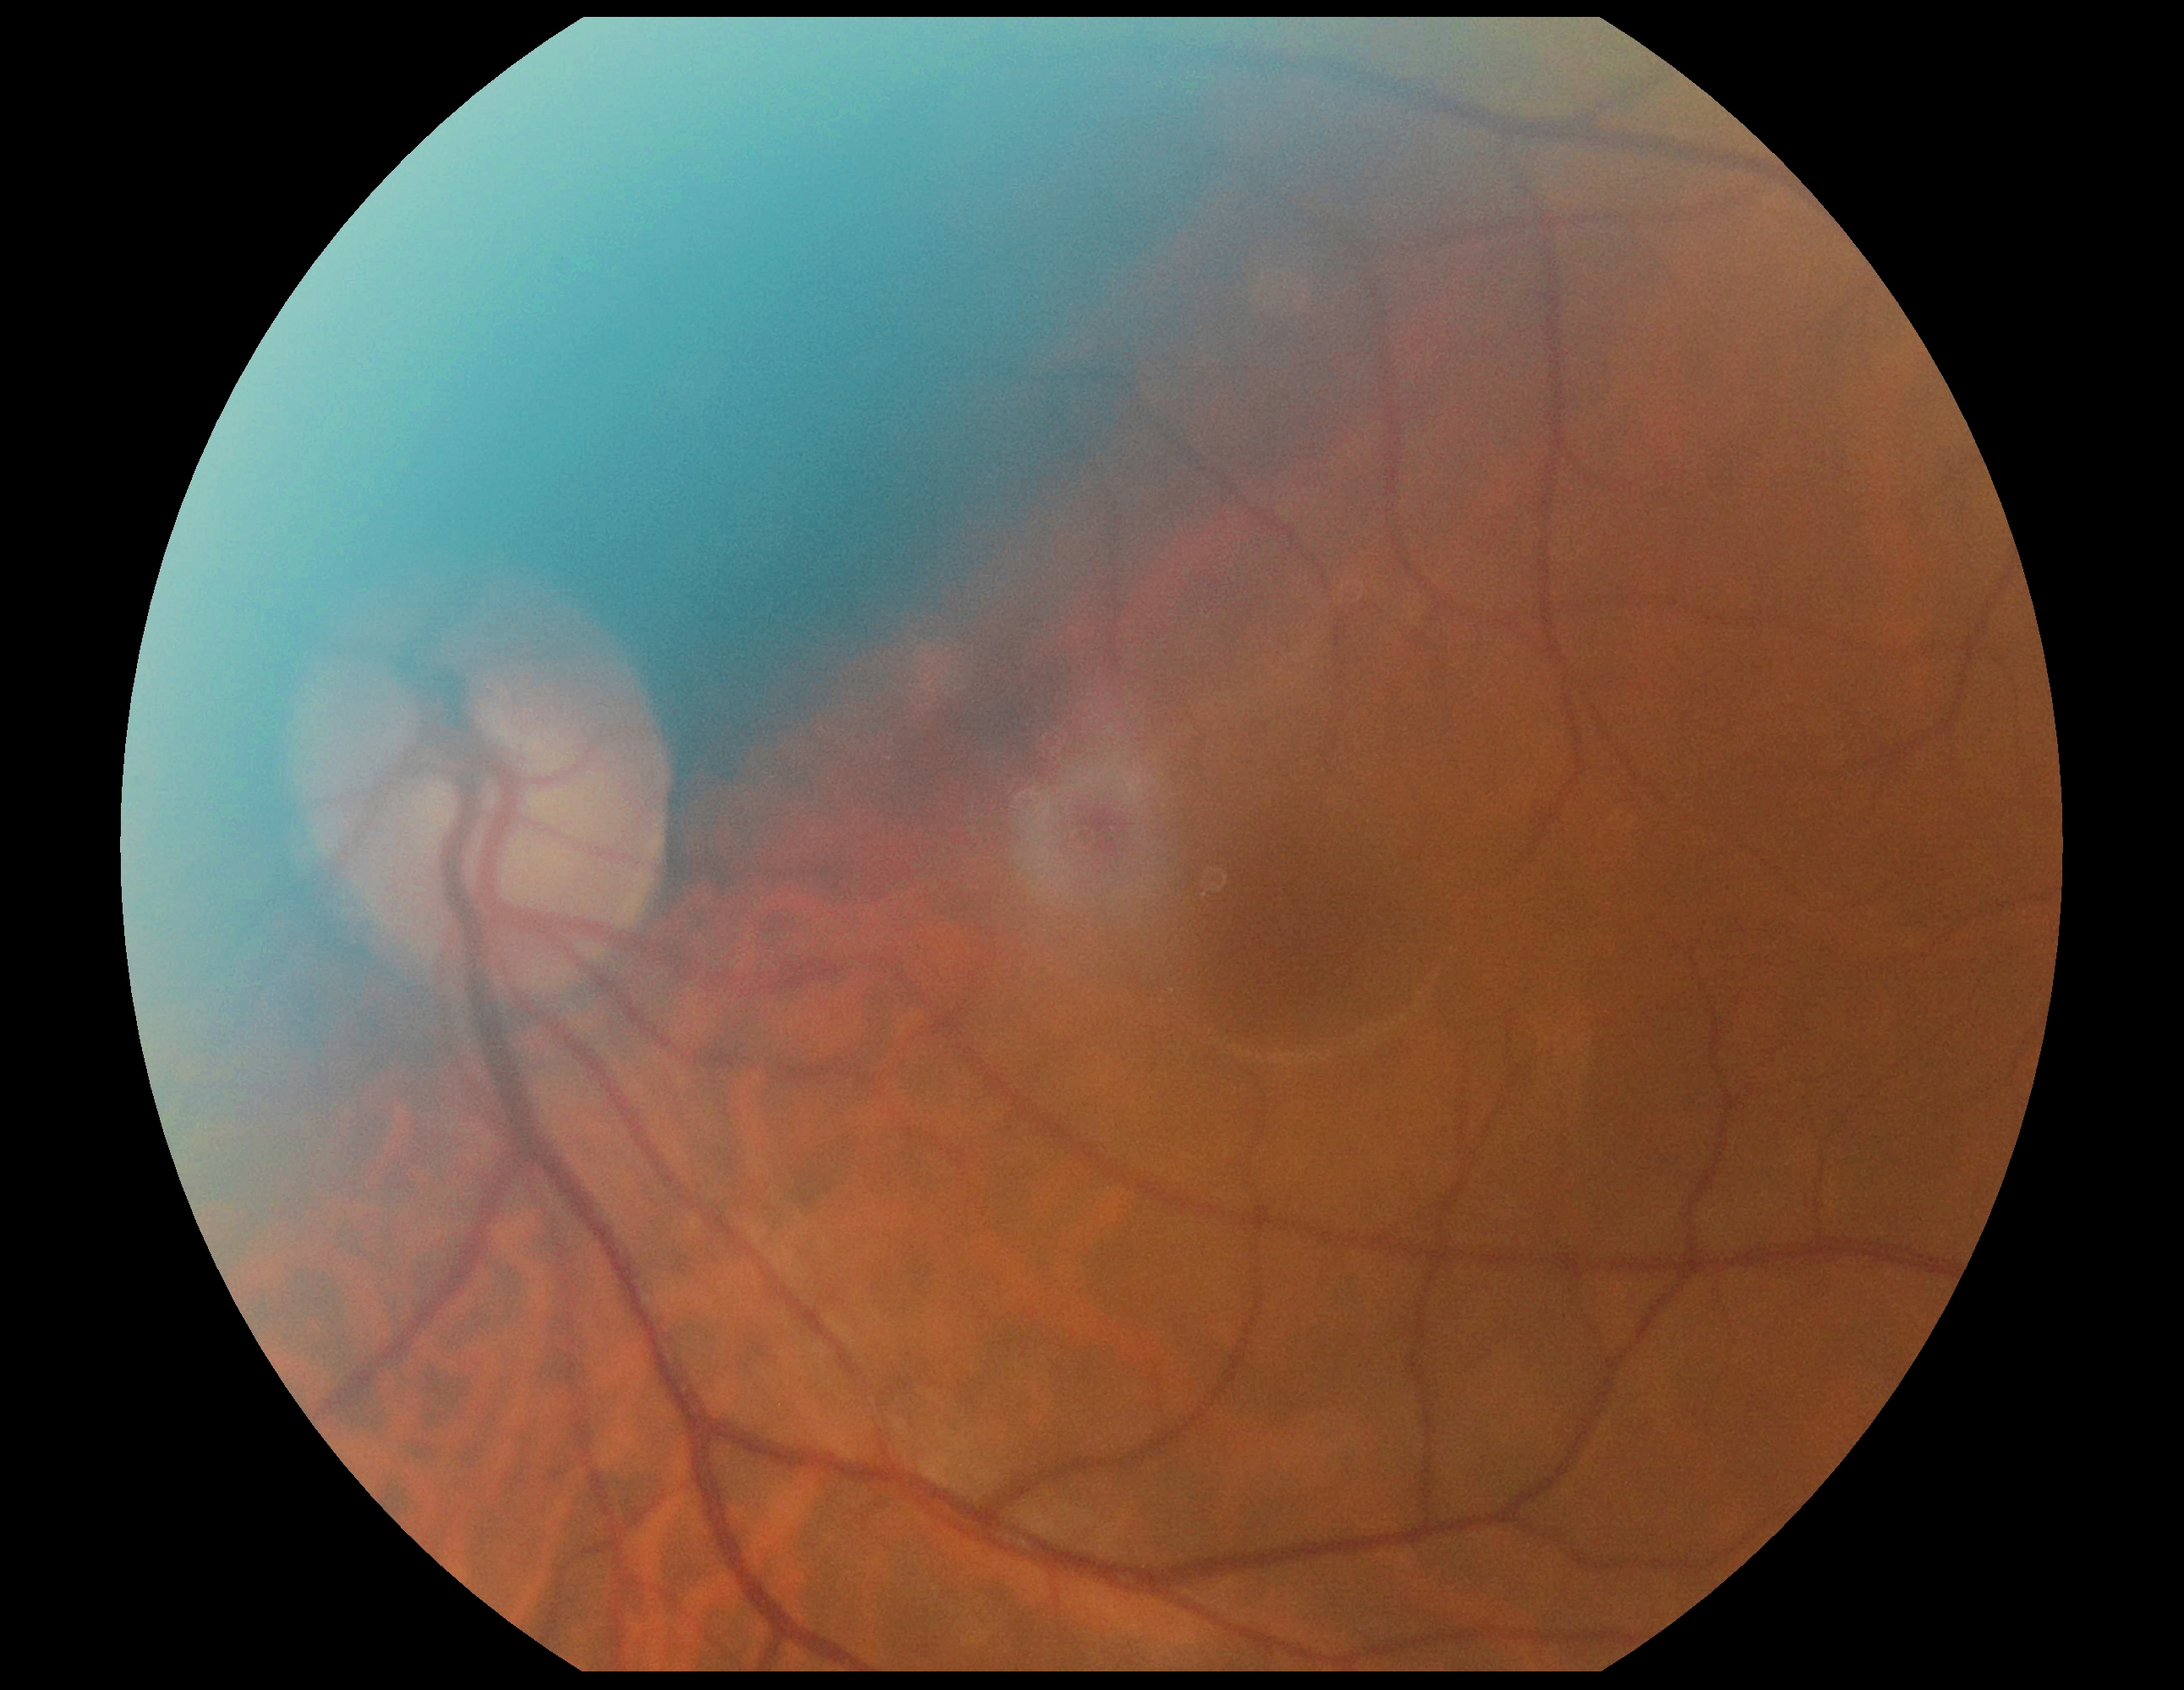 Diabetic retinopathy severity is no apparent retinopathy (grade 0). No diabetic retinal disease findings.